Fundus photo — 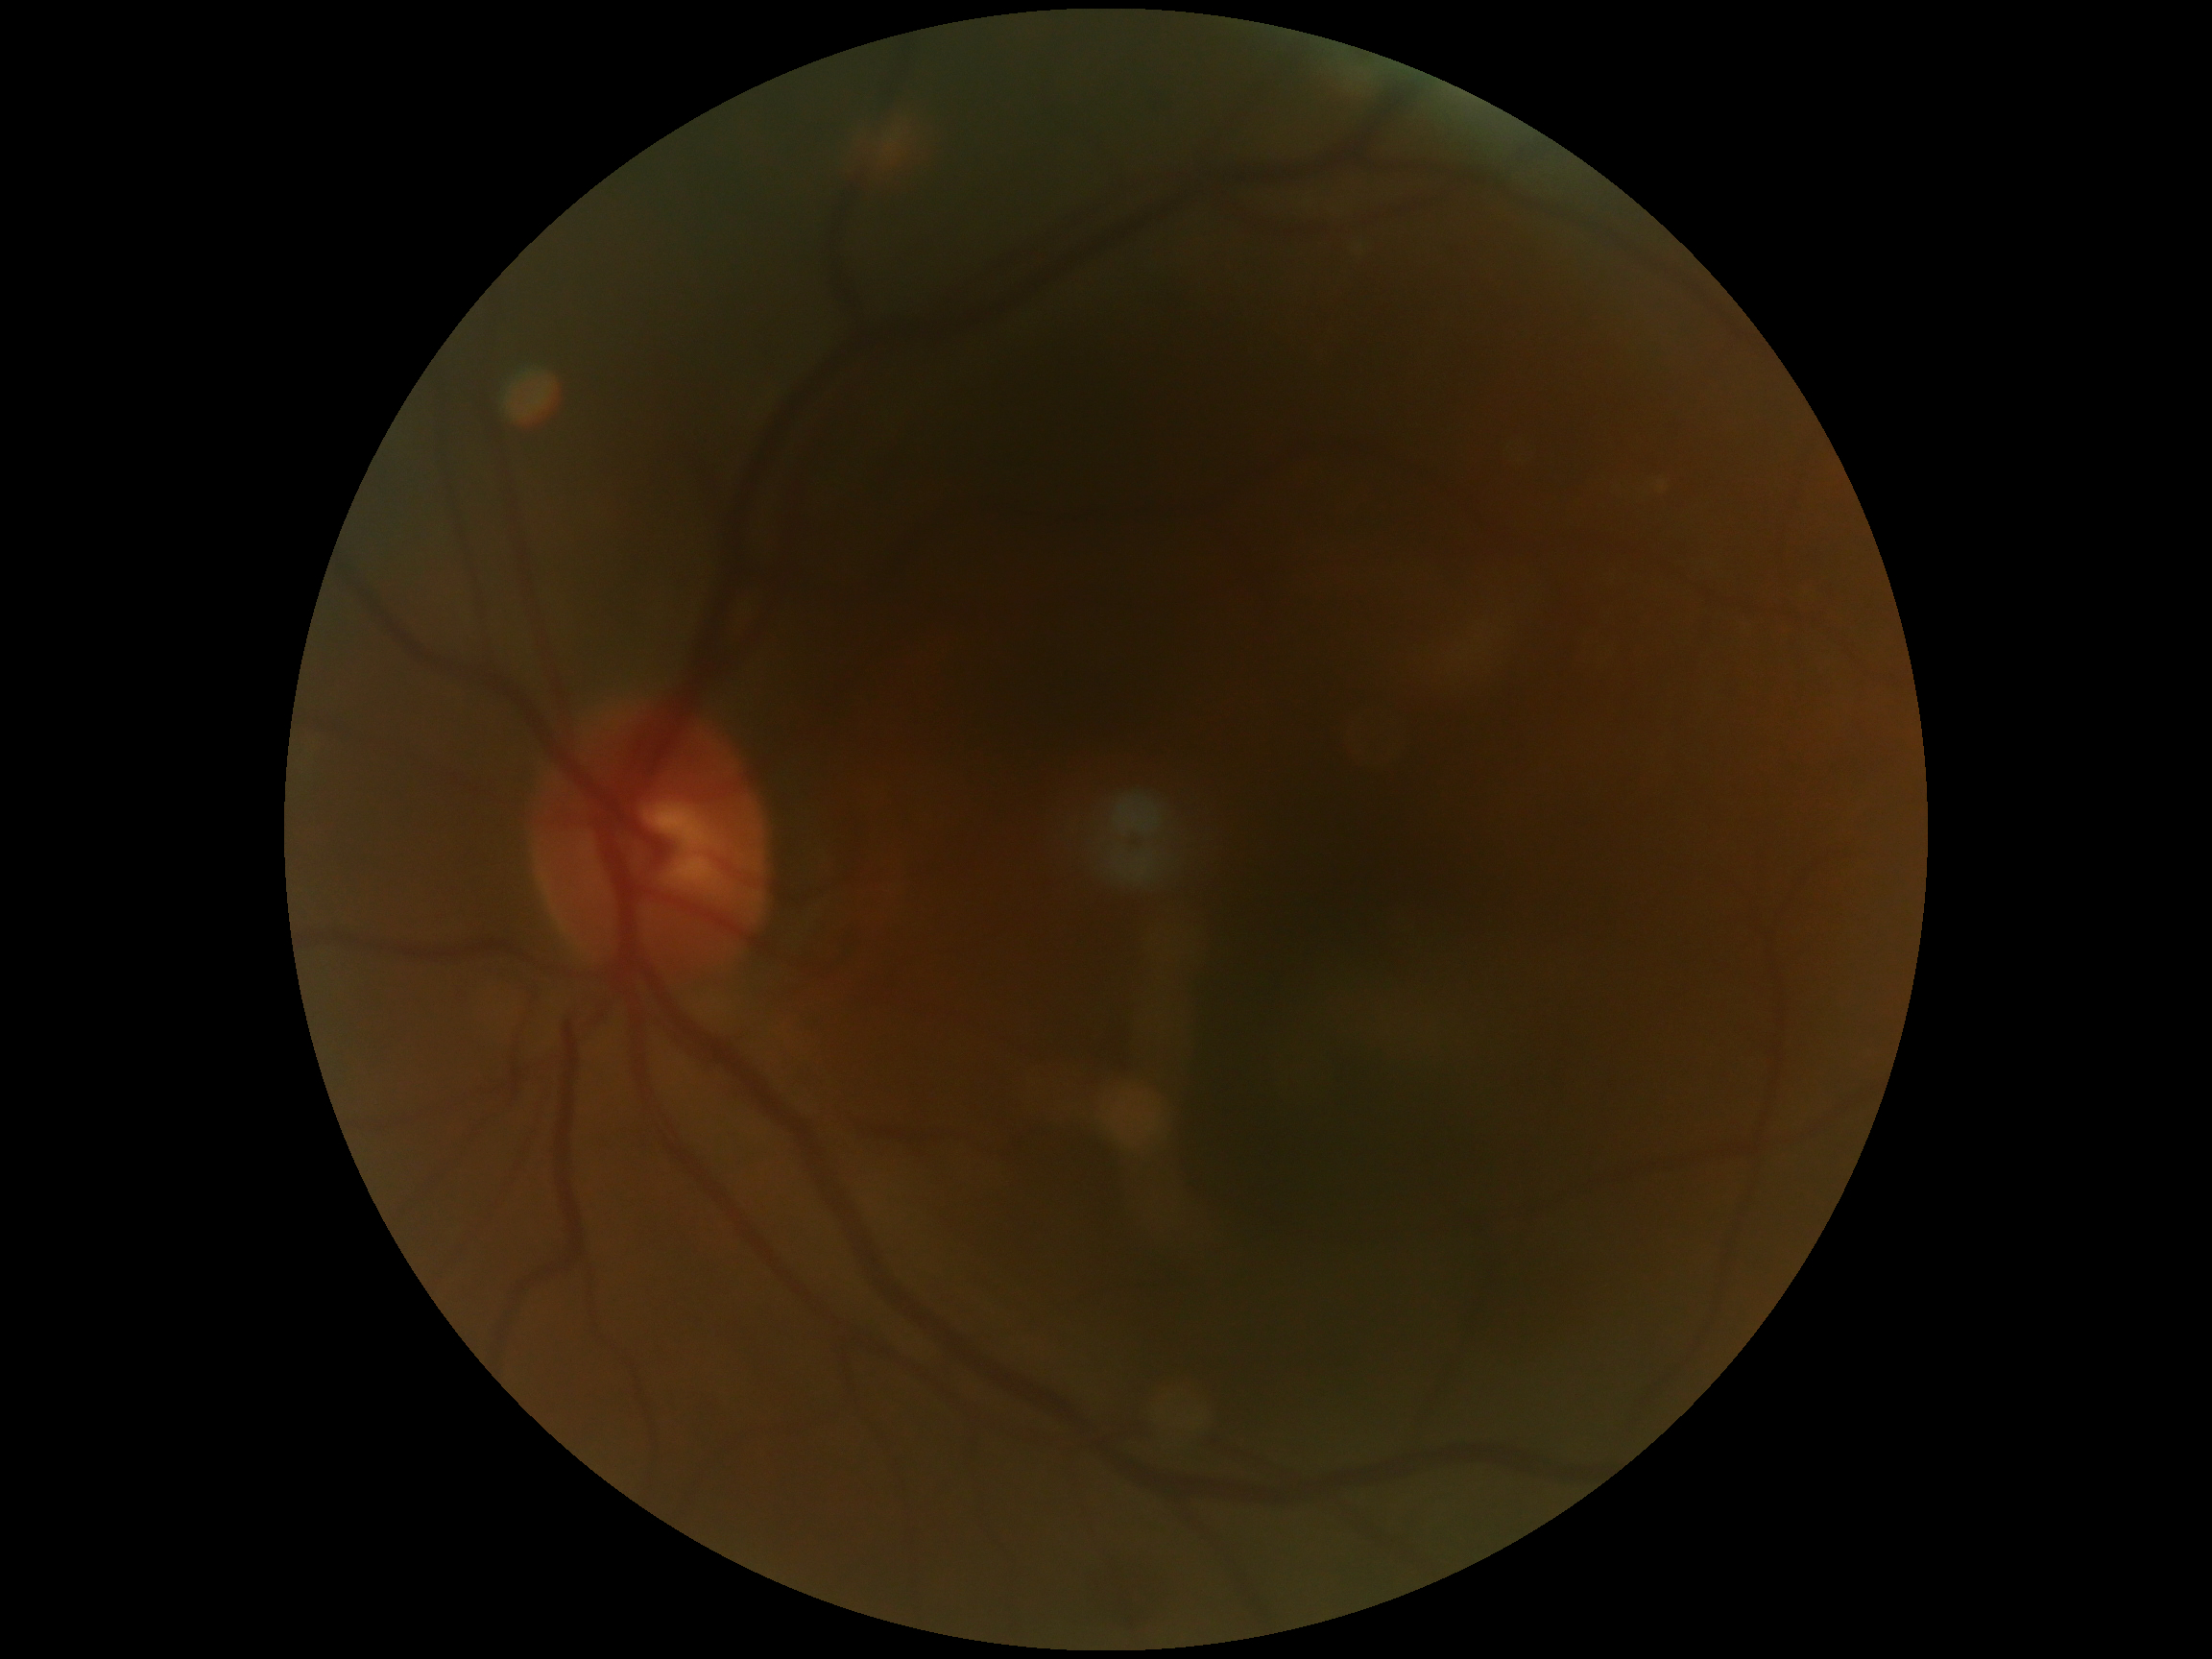

- DR impression: negative for DR
- diabetic retinopathy: grade 0